1240x1240px · wide-field fundus image from infant ROP screening · 100° field of view (Phoenix ICON): 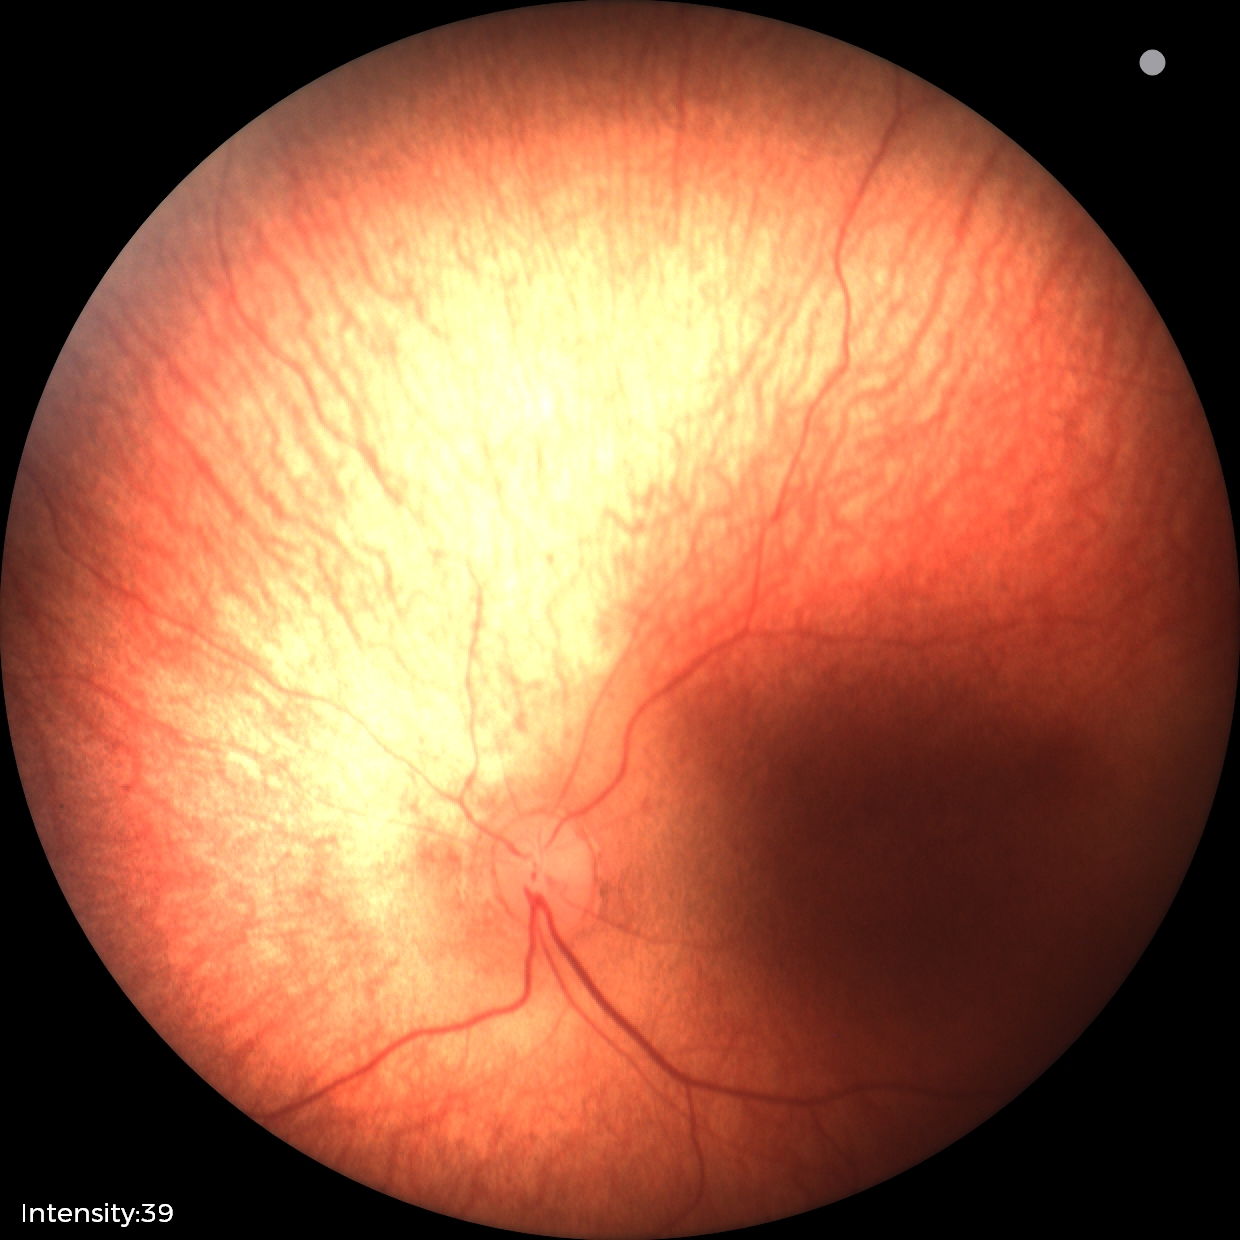

No retinal pathology identified on screening.